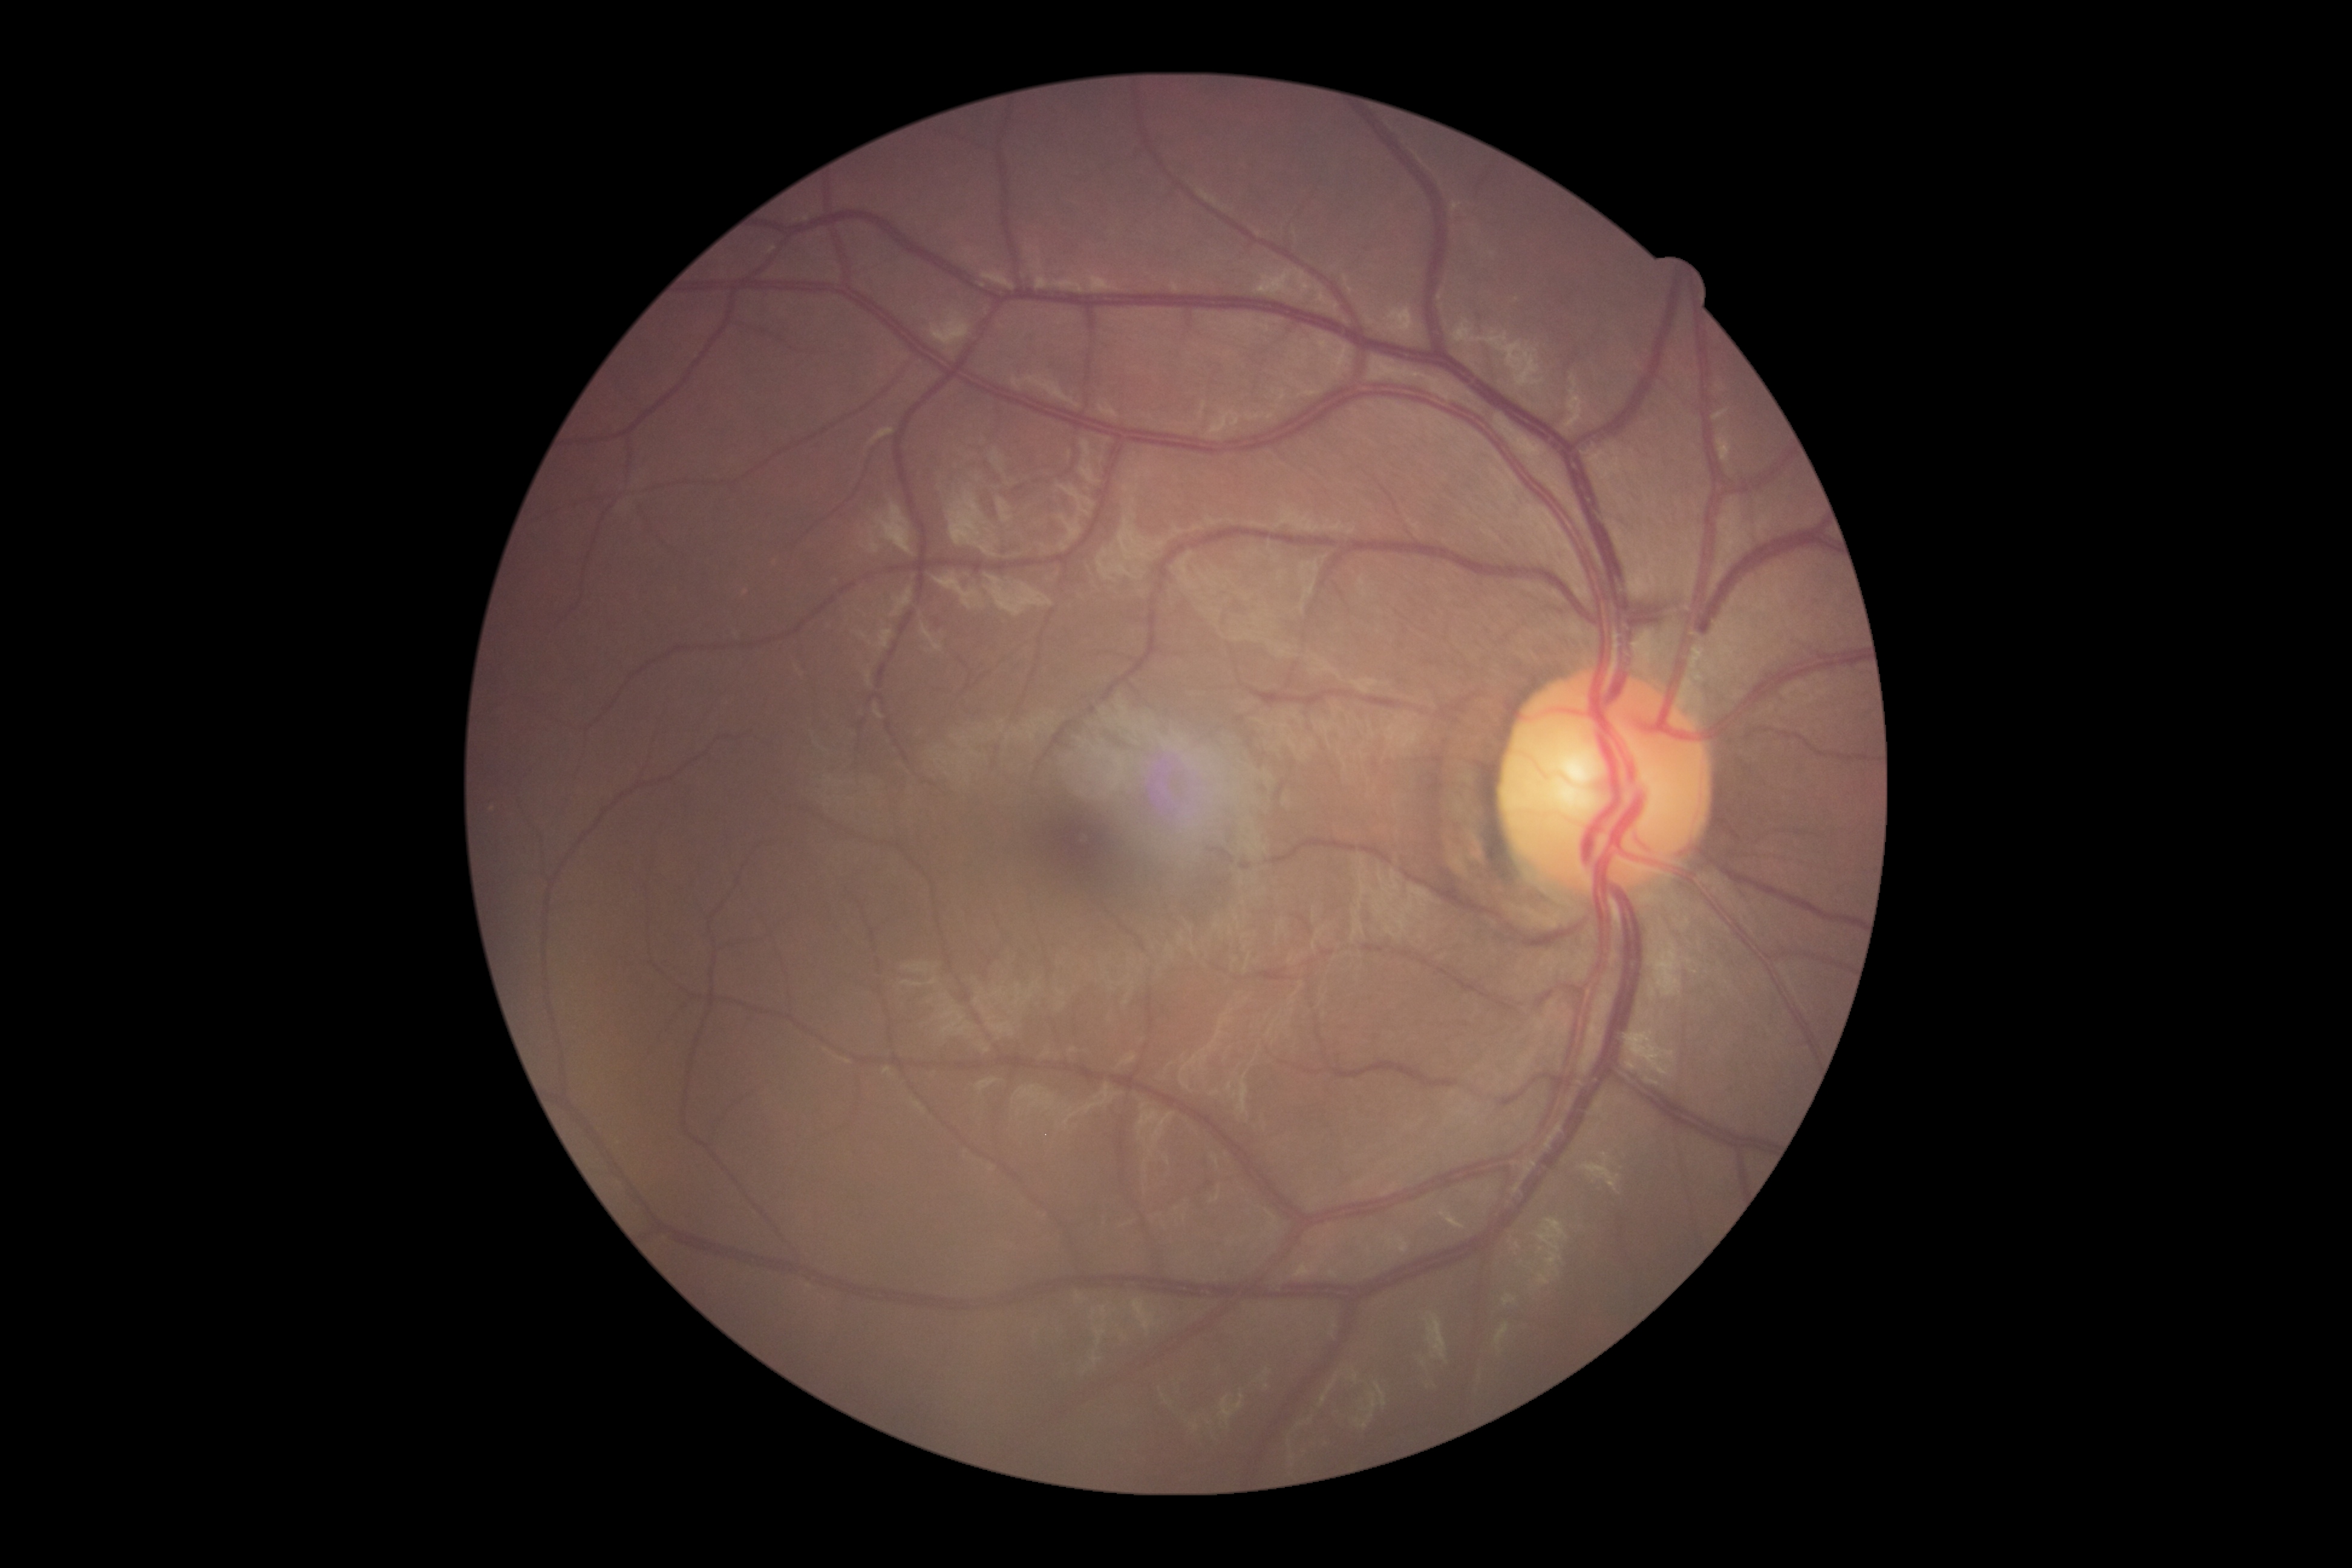
Annotations:
* diabetic retinopathy — grade 0
* DR impression — no apparent DR